Acquired with a Topcon TRC-50DX, posterior pole field covering the optic disc and macula.
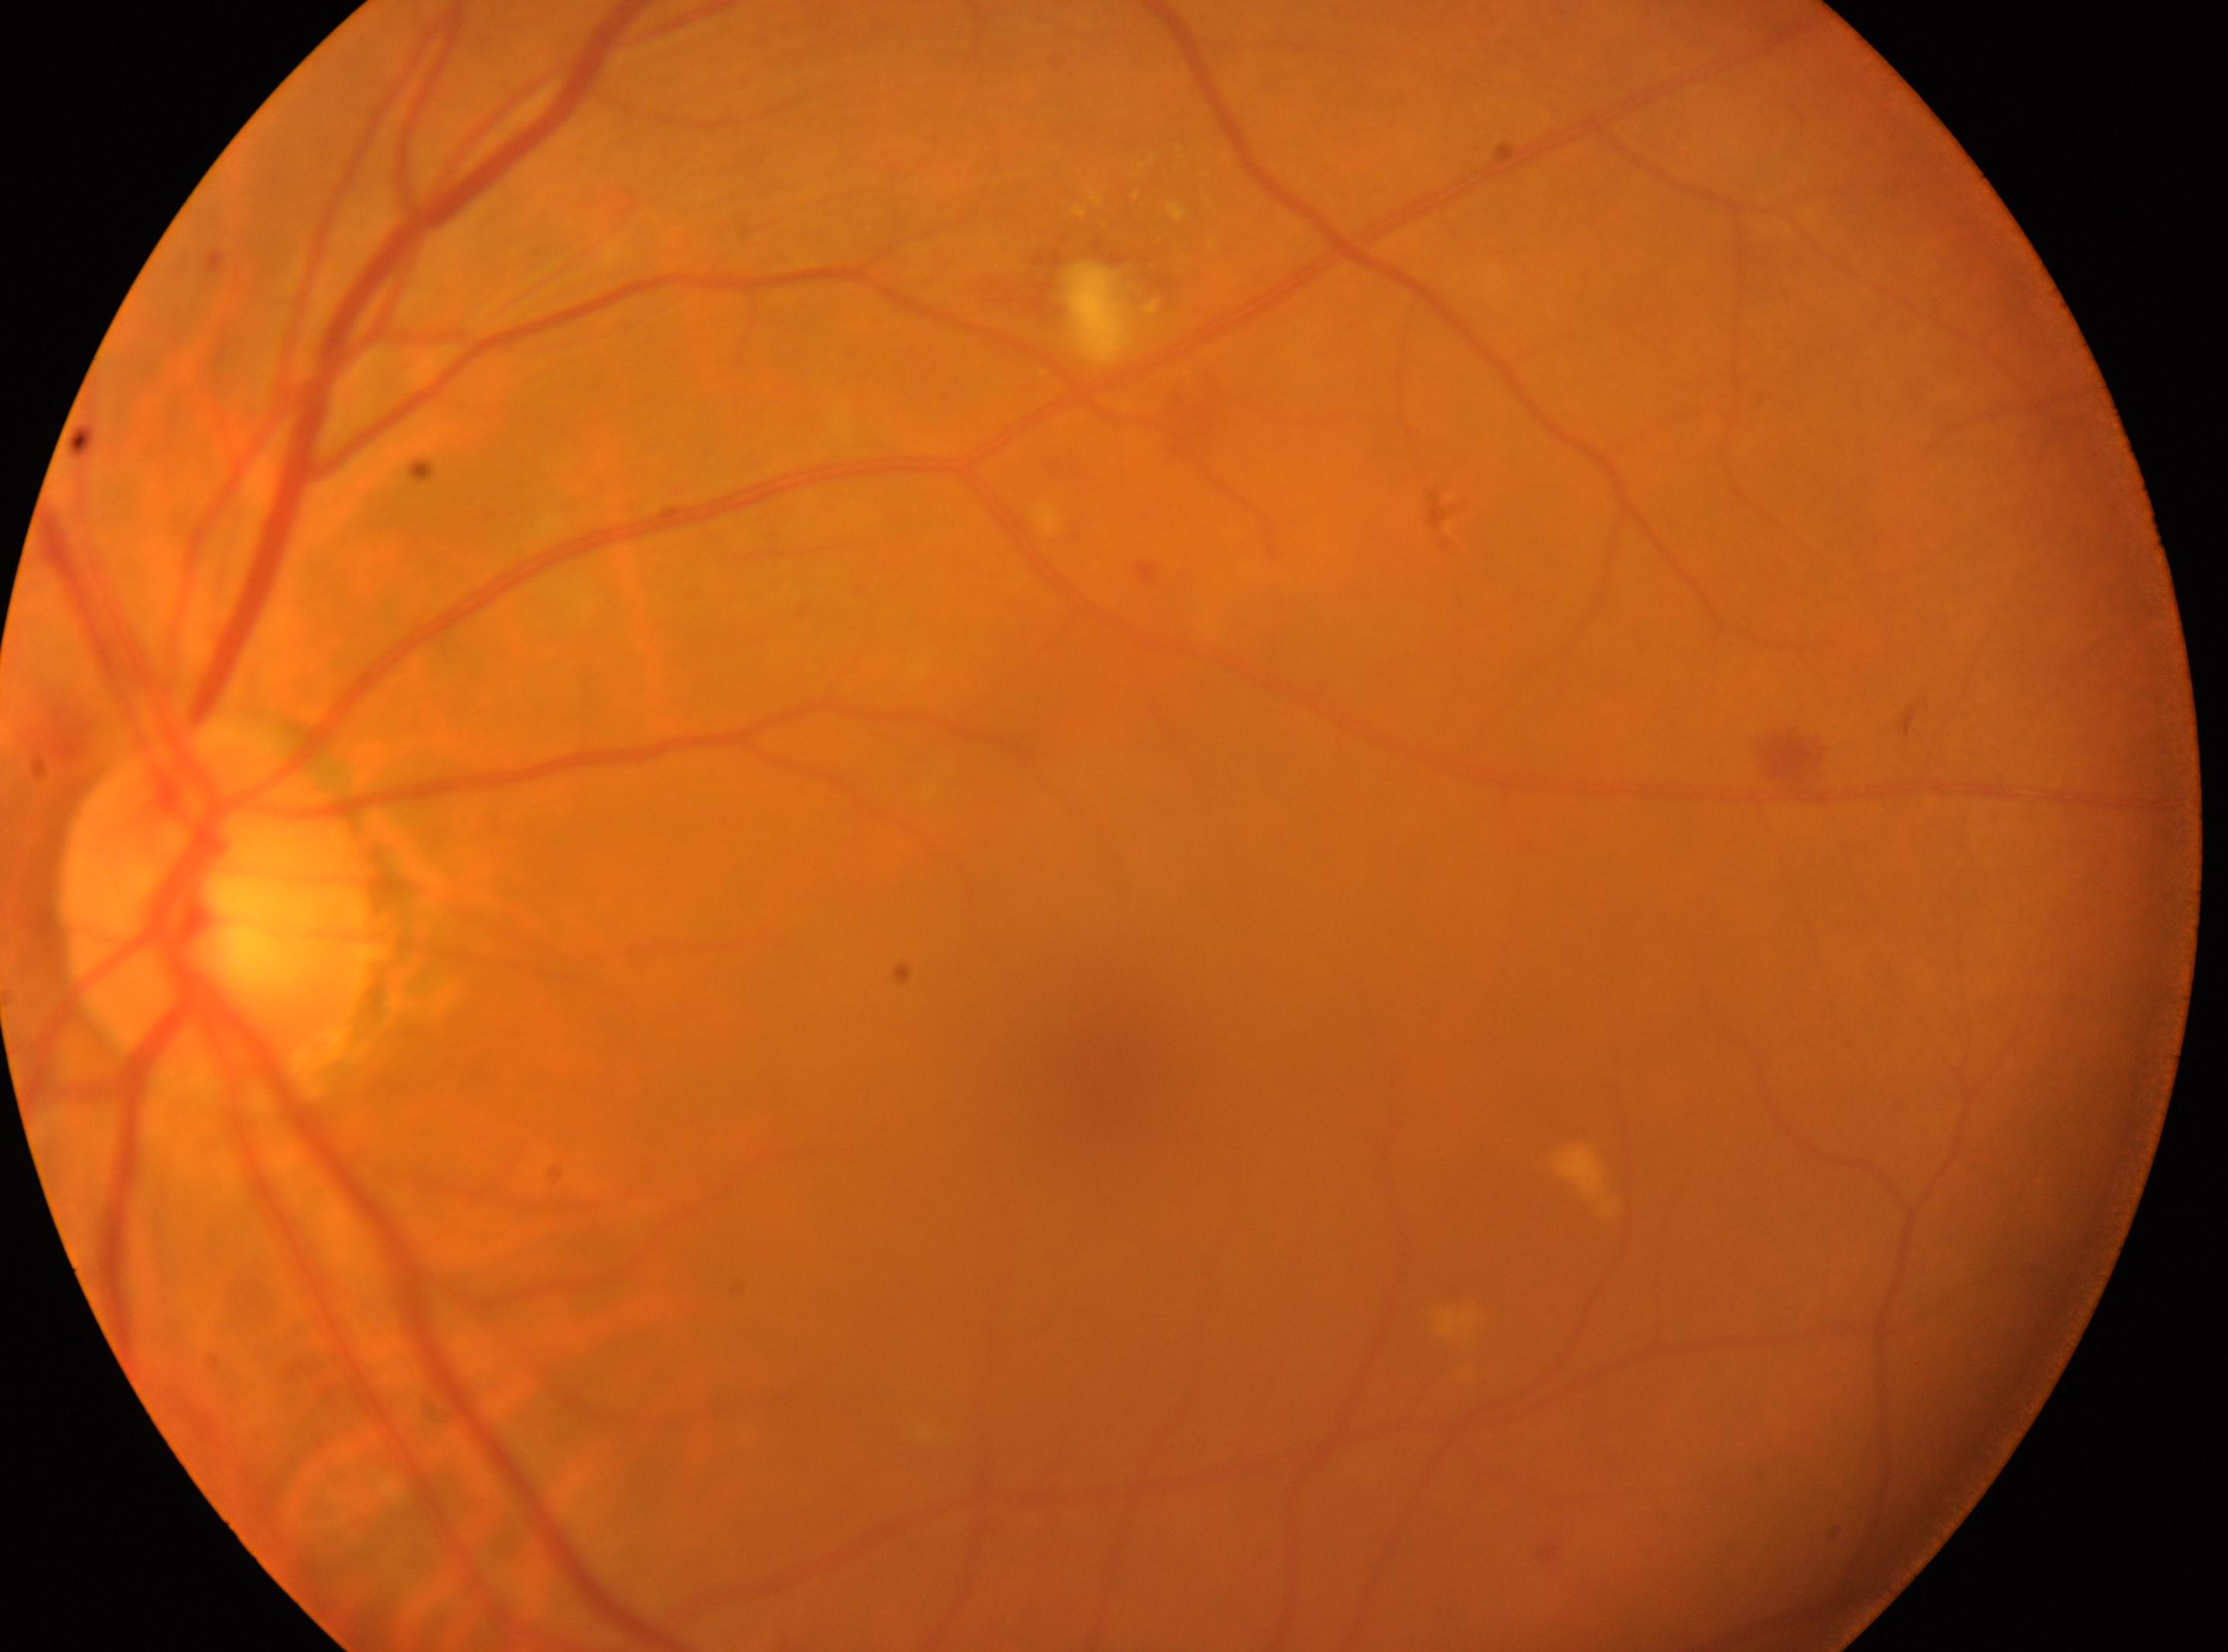
Macula center: (x: 1108, y: 1094).
This is the left eye.
DR stage is 2.
Optic disc located at (x: 219, y: 914).
The retinopathy is classified as non-proliferative diabetic retinopathy.